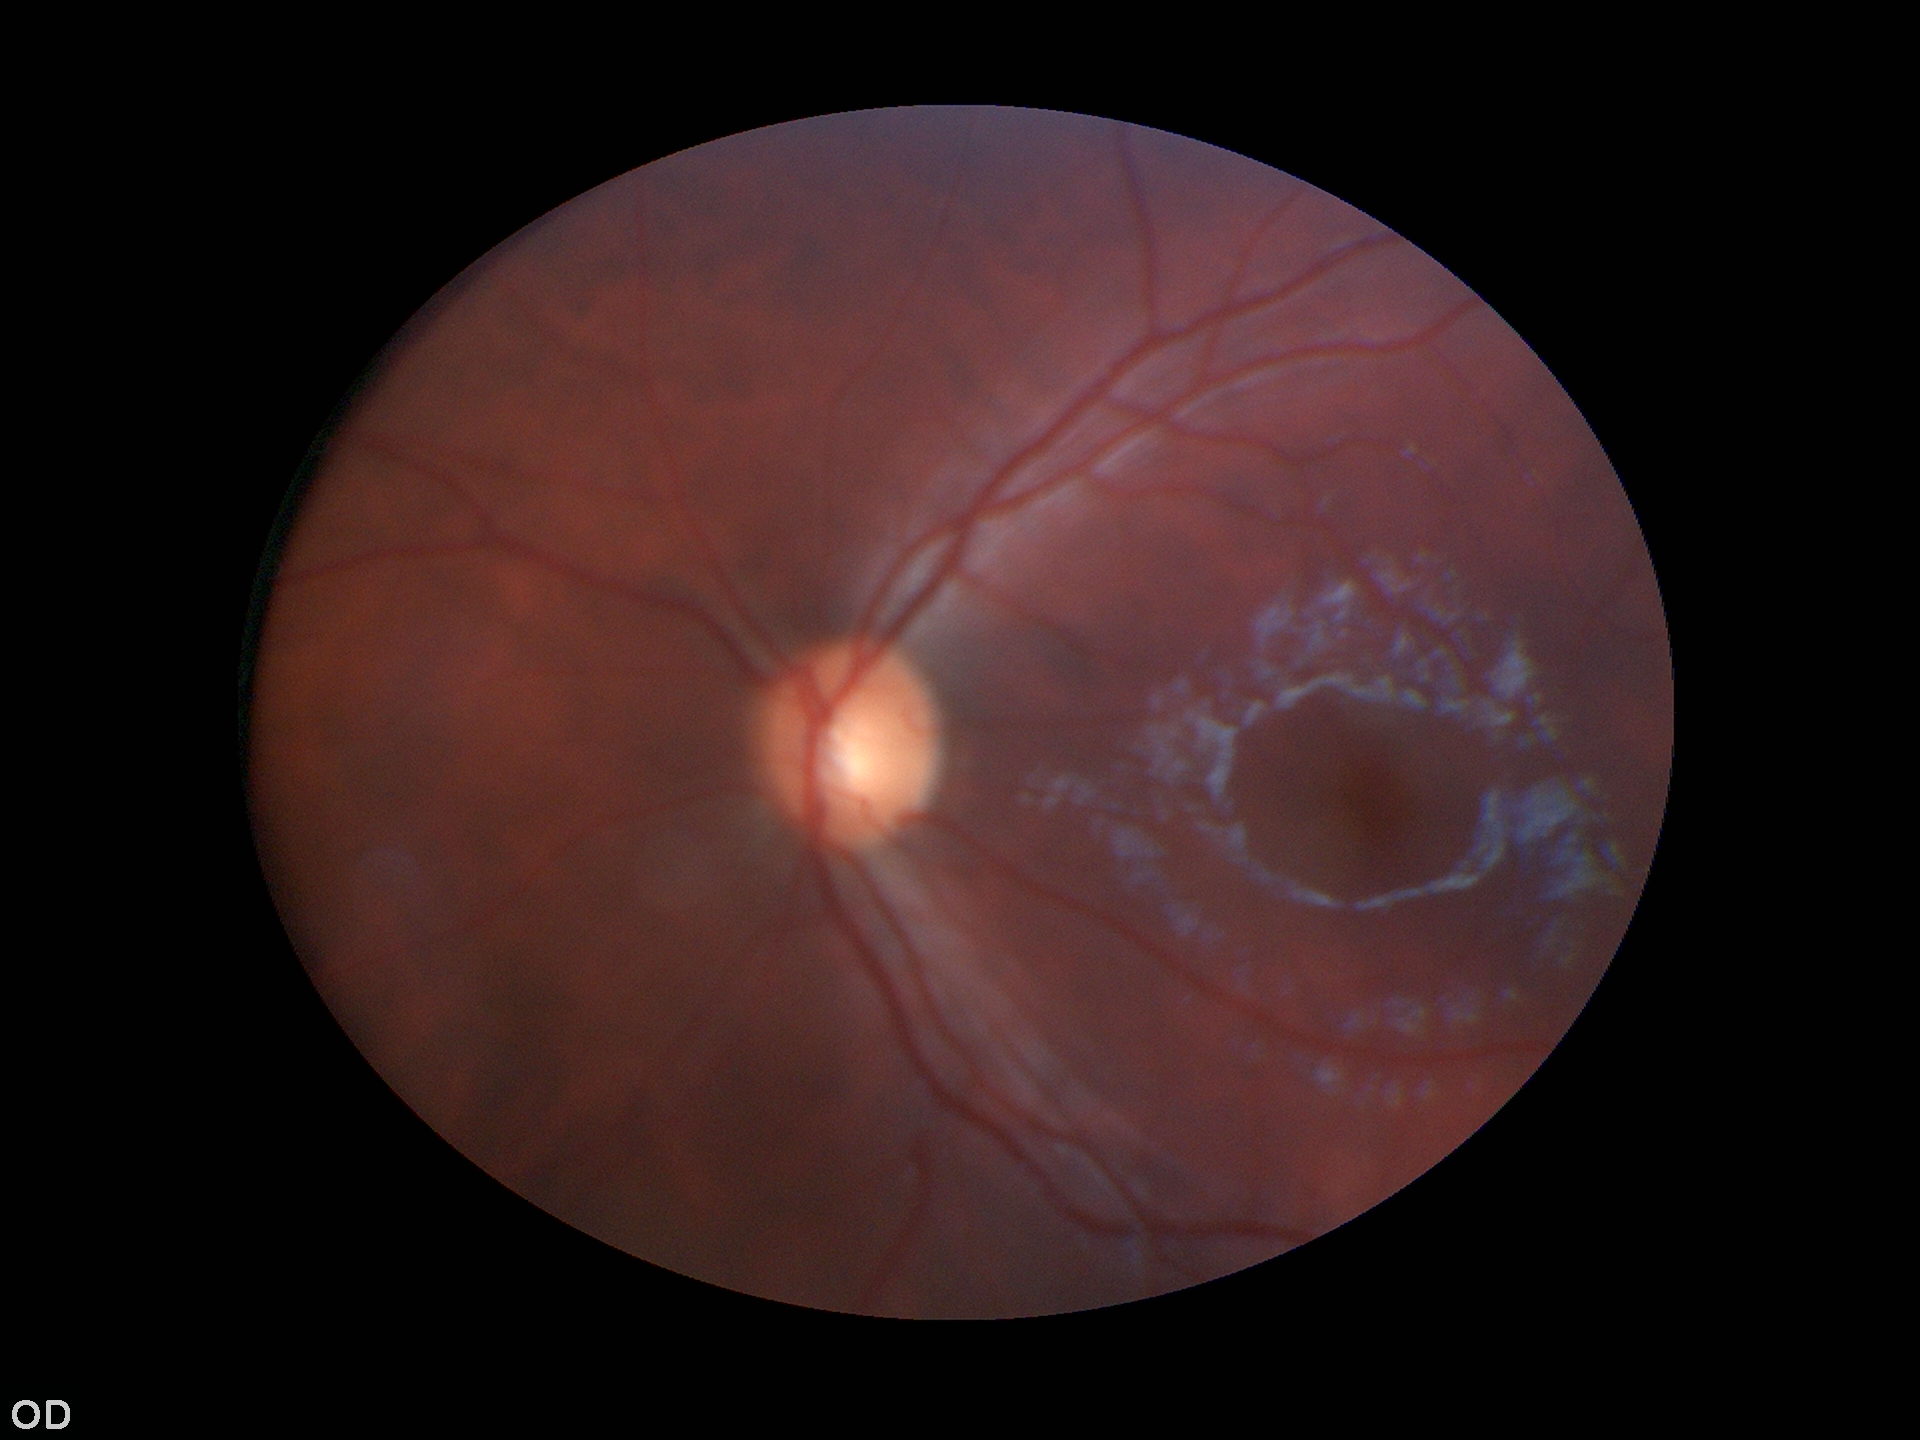
Q: What is the VCDR?
A: 0.54
Q: Is there glaucoma suspicion?
A: negative
Q: Horizontal CDR?
A: 0.52